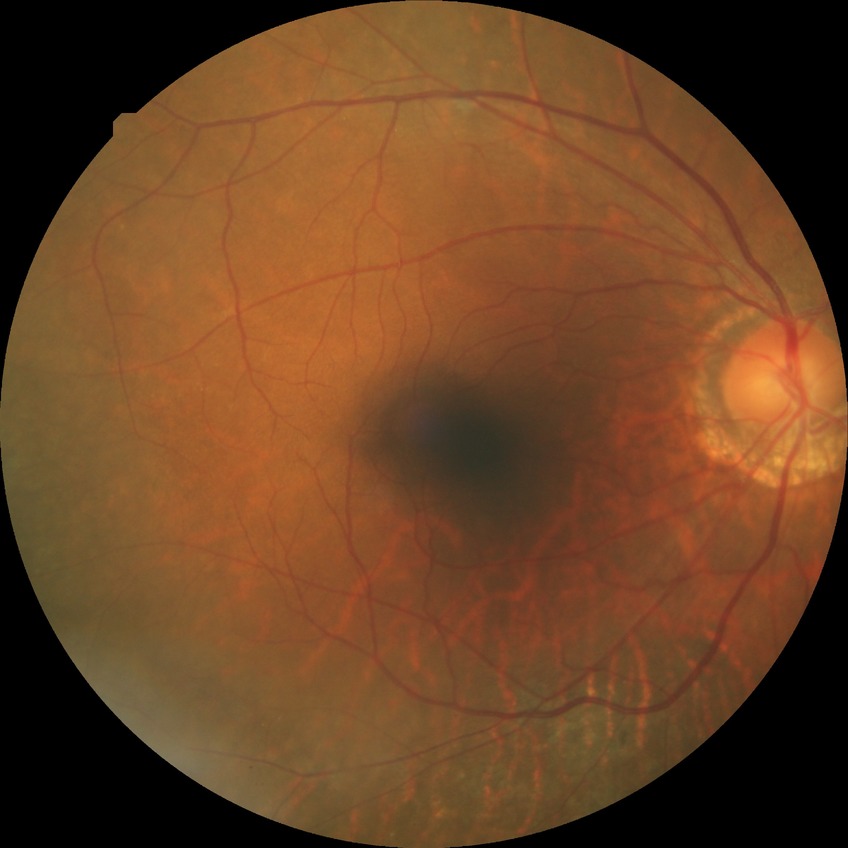

Diabetic retinopathy (DR) is no diabetic retinopathy (NDR).